848 by 848 pixels. Diabetic retinopathy graded by the modified Davis classification. Posterior pole photograph
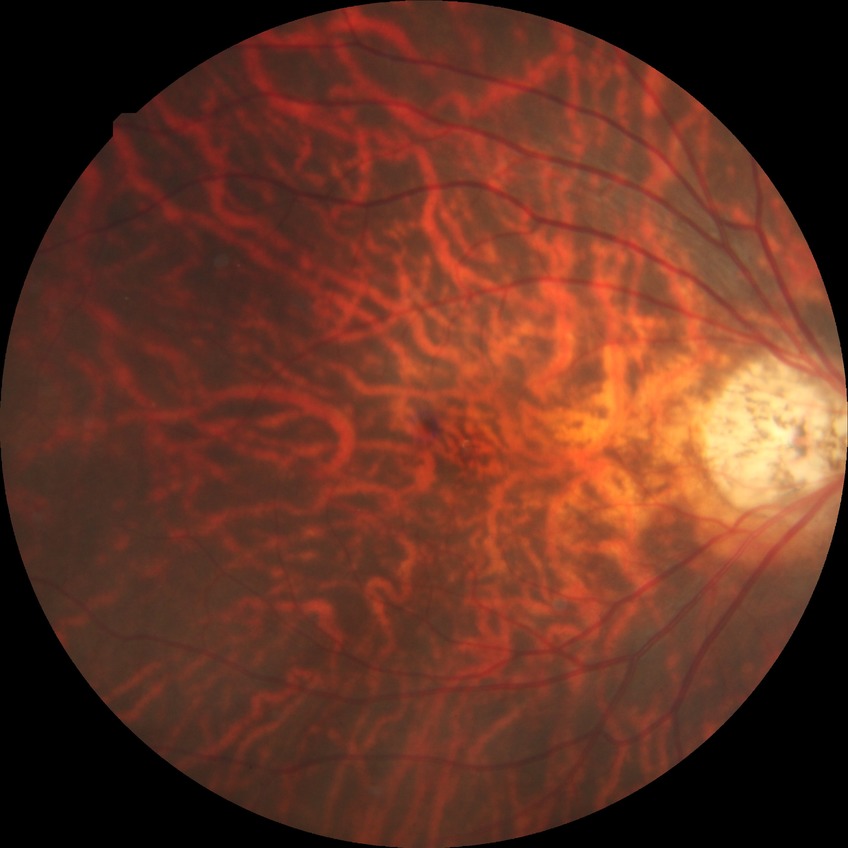
Davis grading: no diabetic retinopathy.